Posterior pole view; captured on a Topcon TRC-50DX fundus camera; 50° FOV; 2228 by 1652 pixels: 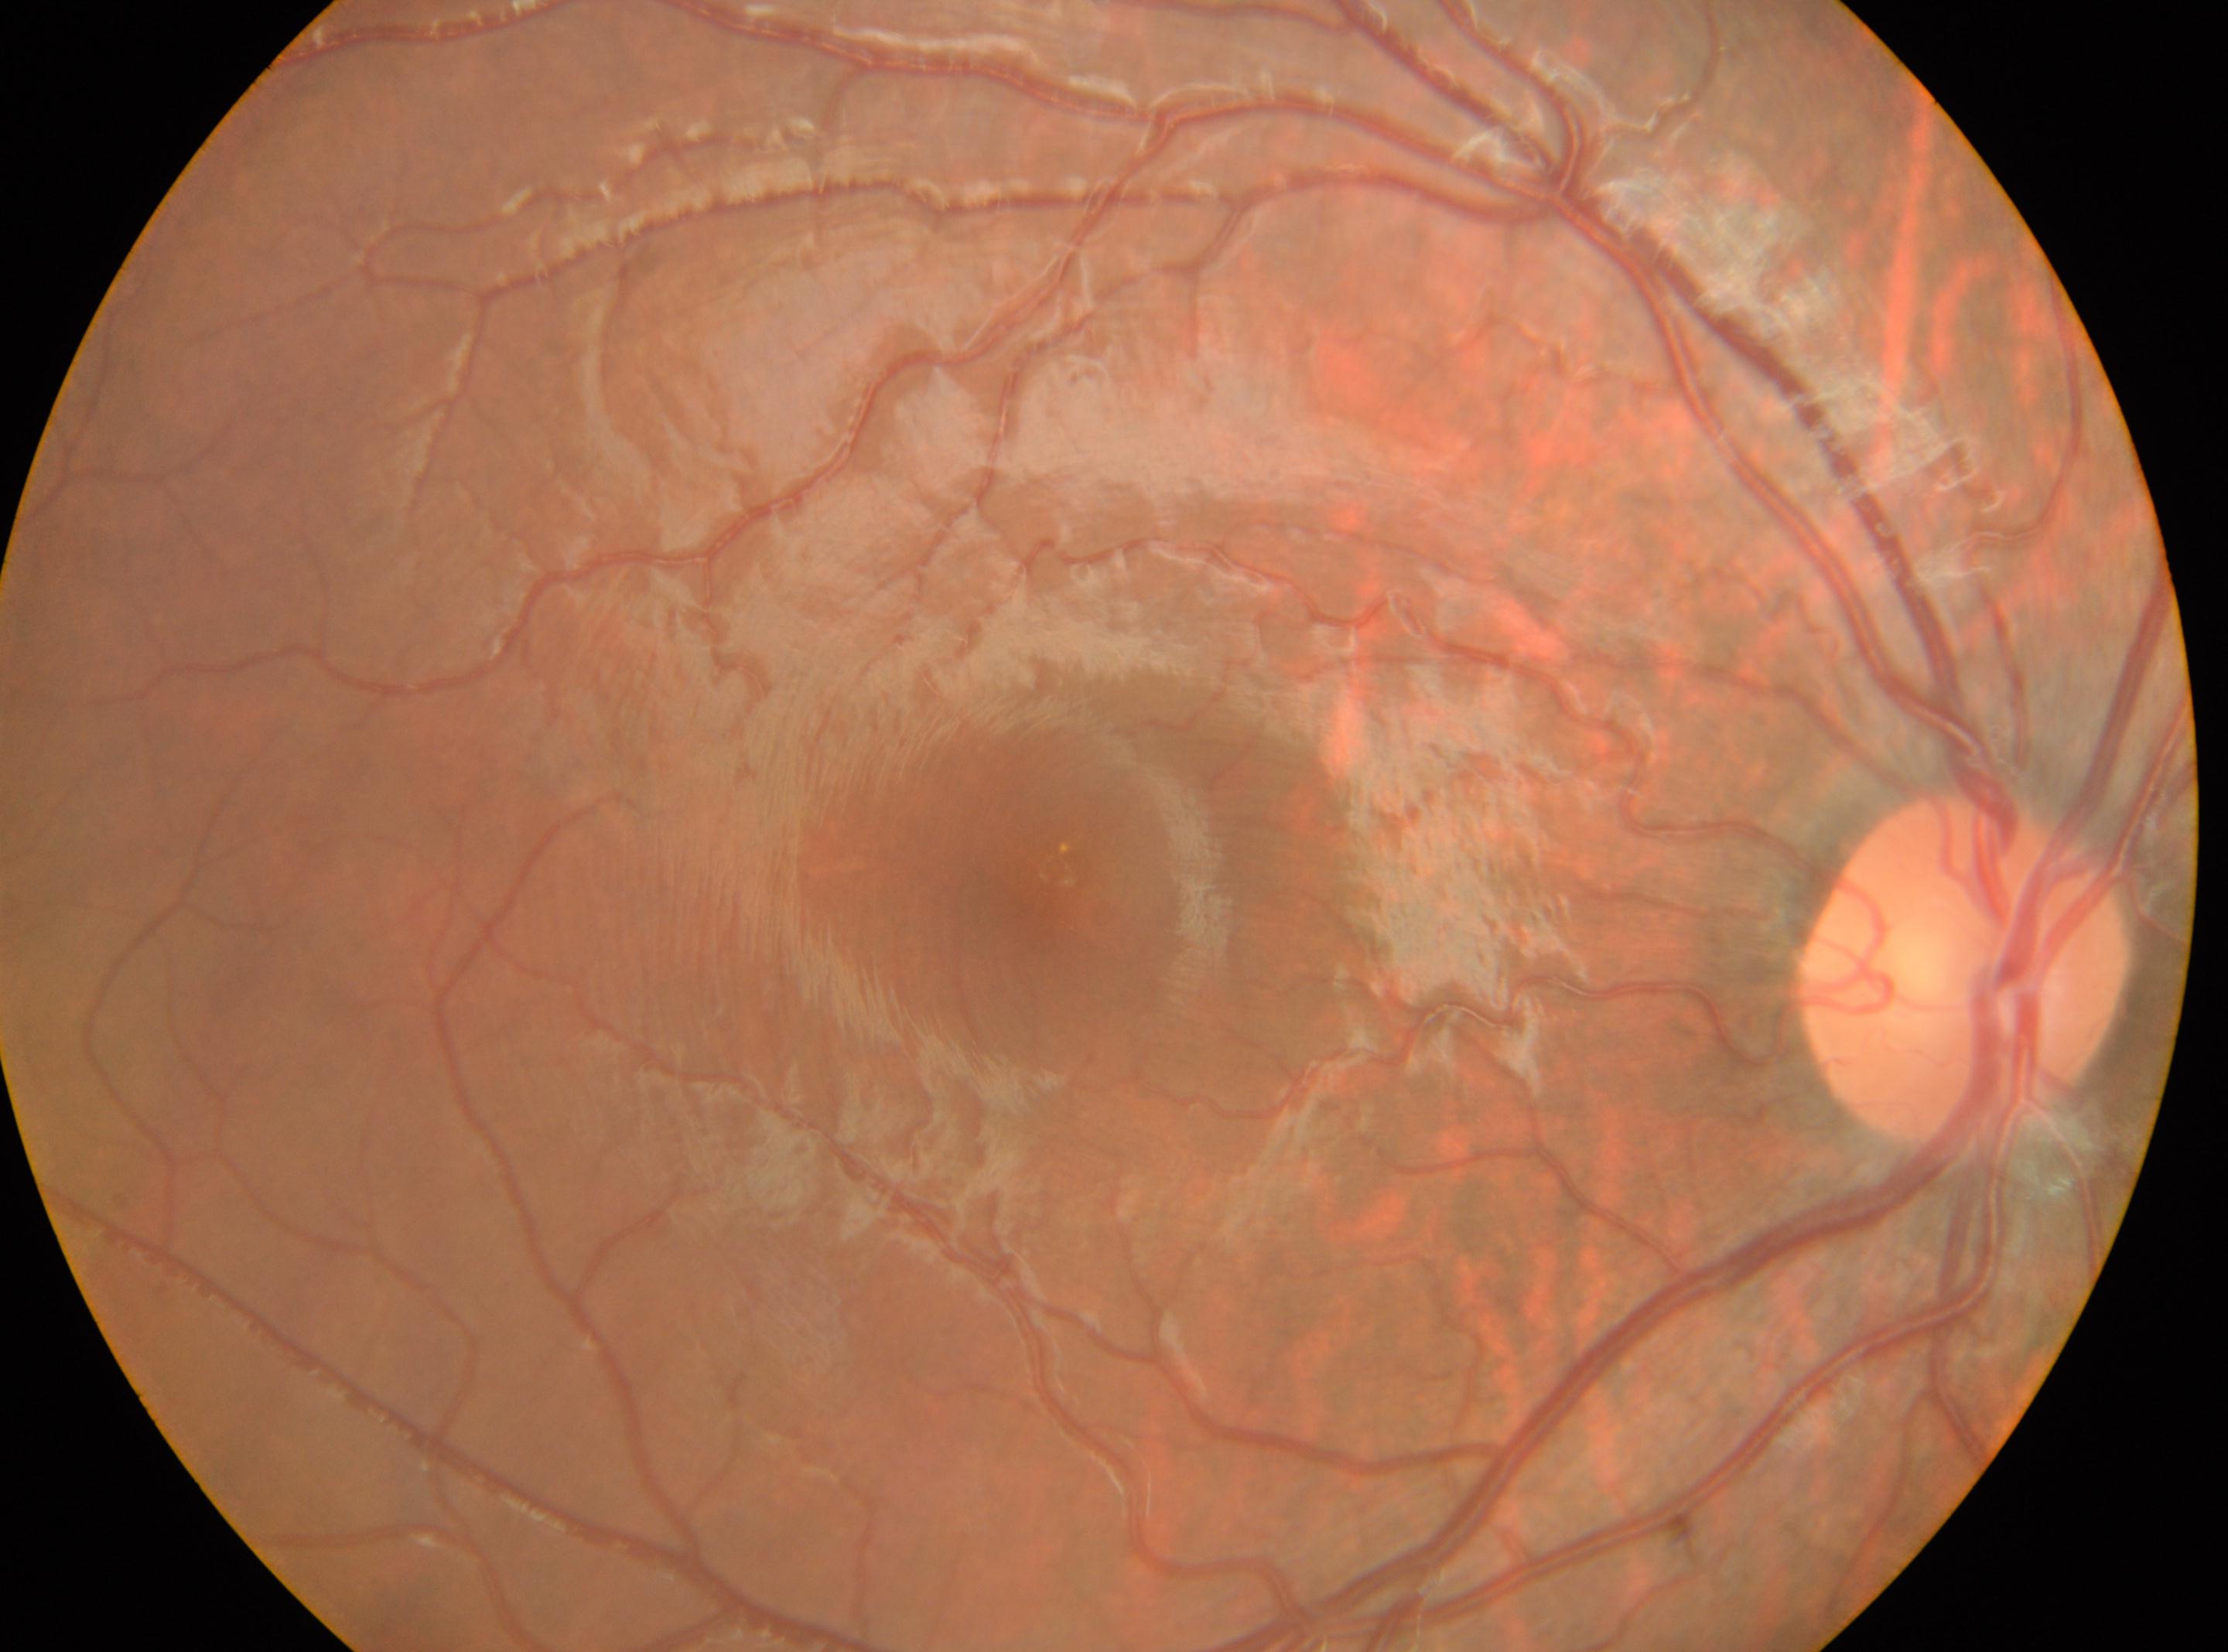
Fovea located at 1055px, 869px. Imaged eye: right. ONH located at 1963px, 970px. DR severity: no apparent diabetic retinopathy (grade 0).